Wide-field fundus photograph from neonatal ROP screening:
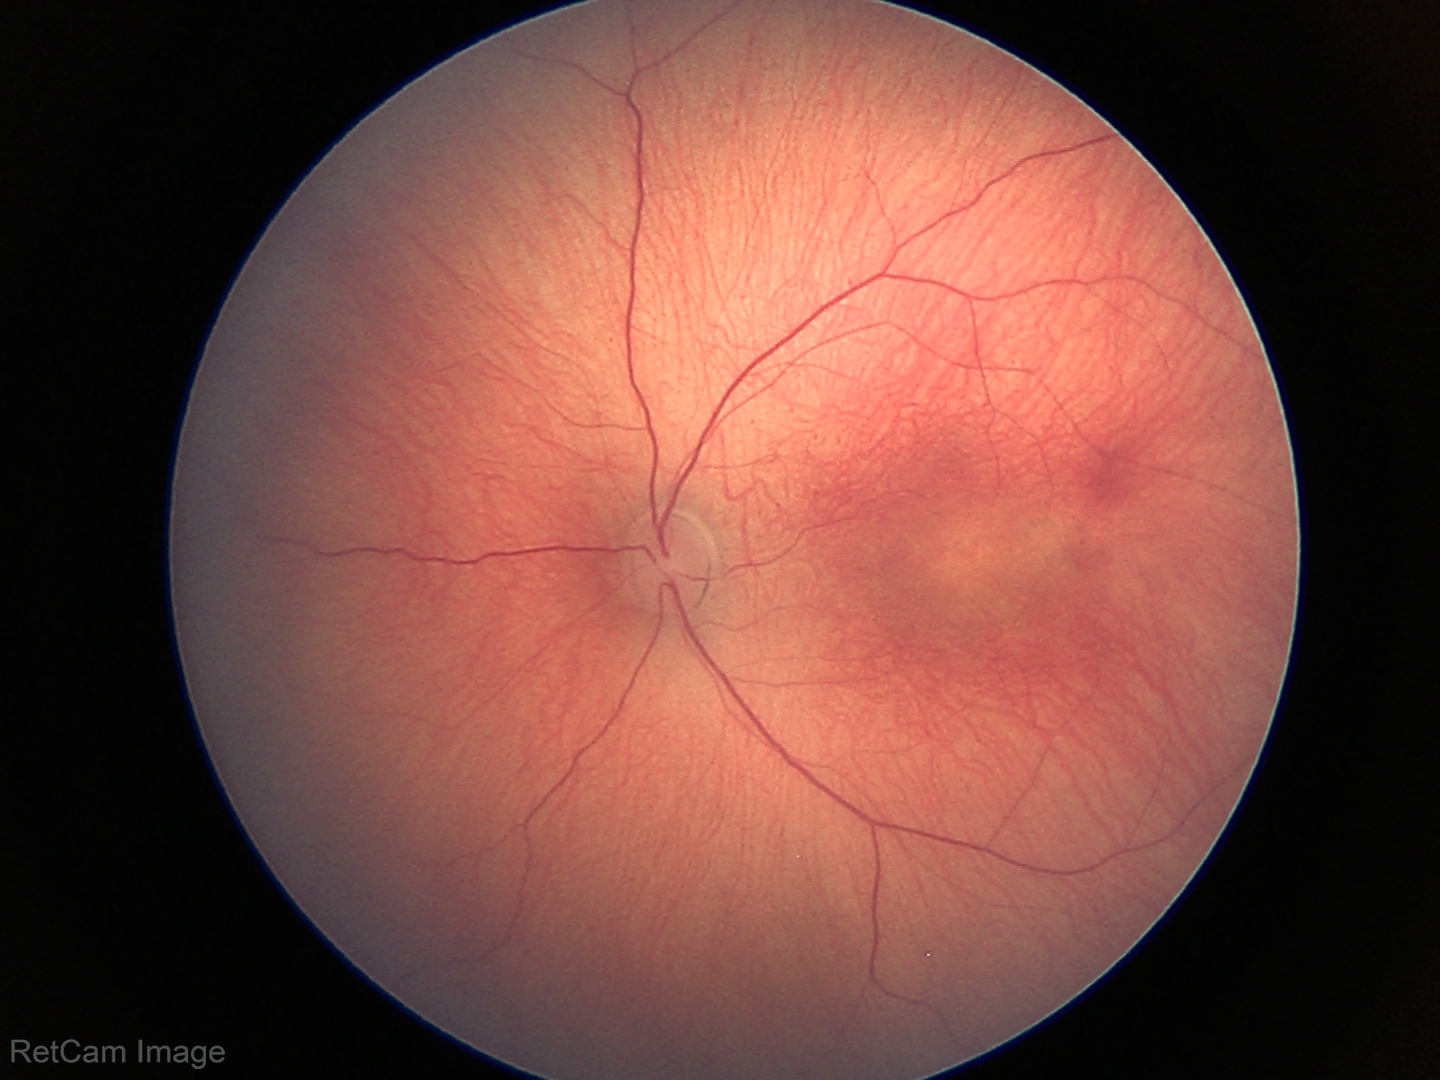 Screening series with status post ROP. Without plus disease.